Retinal fundus photograph
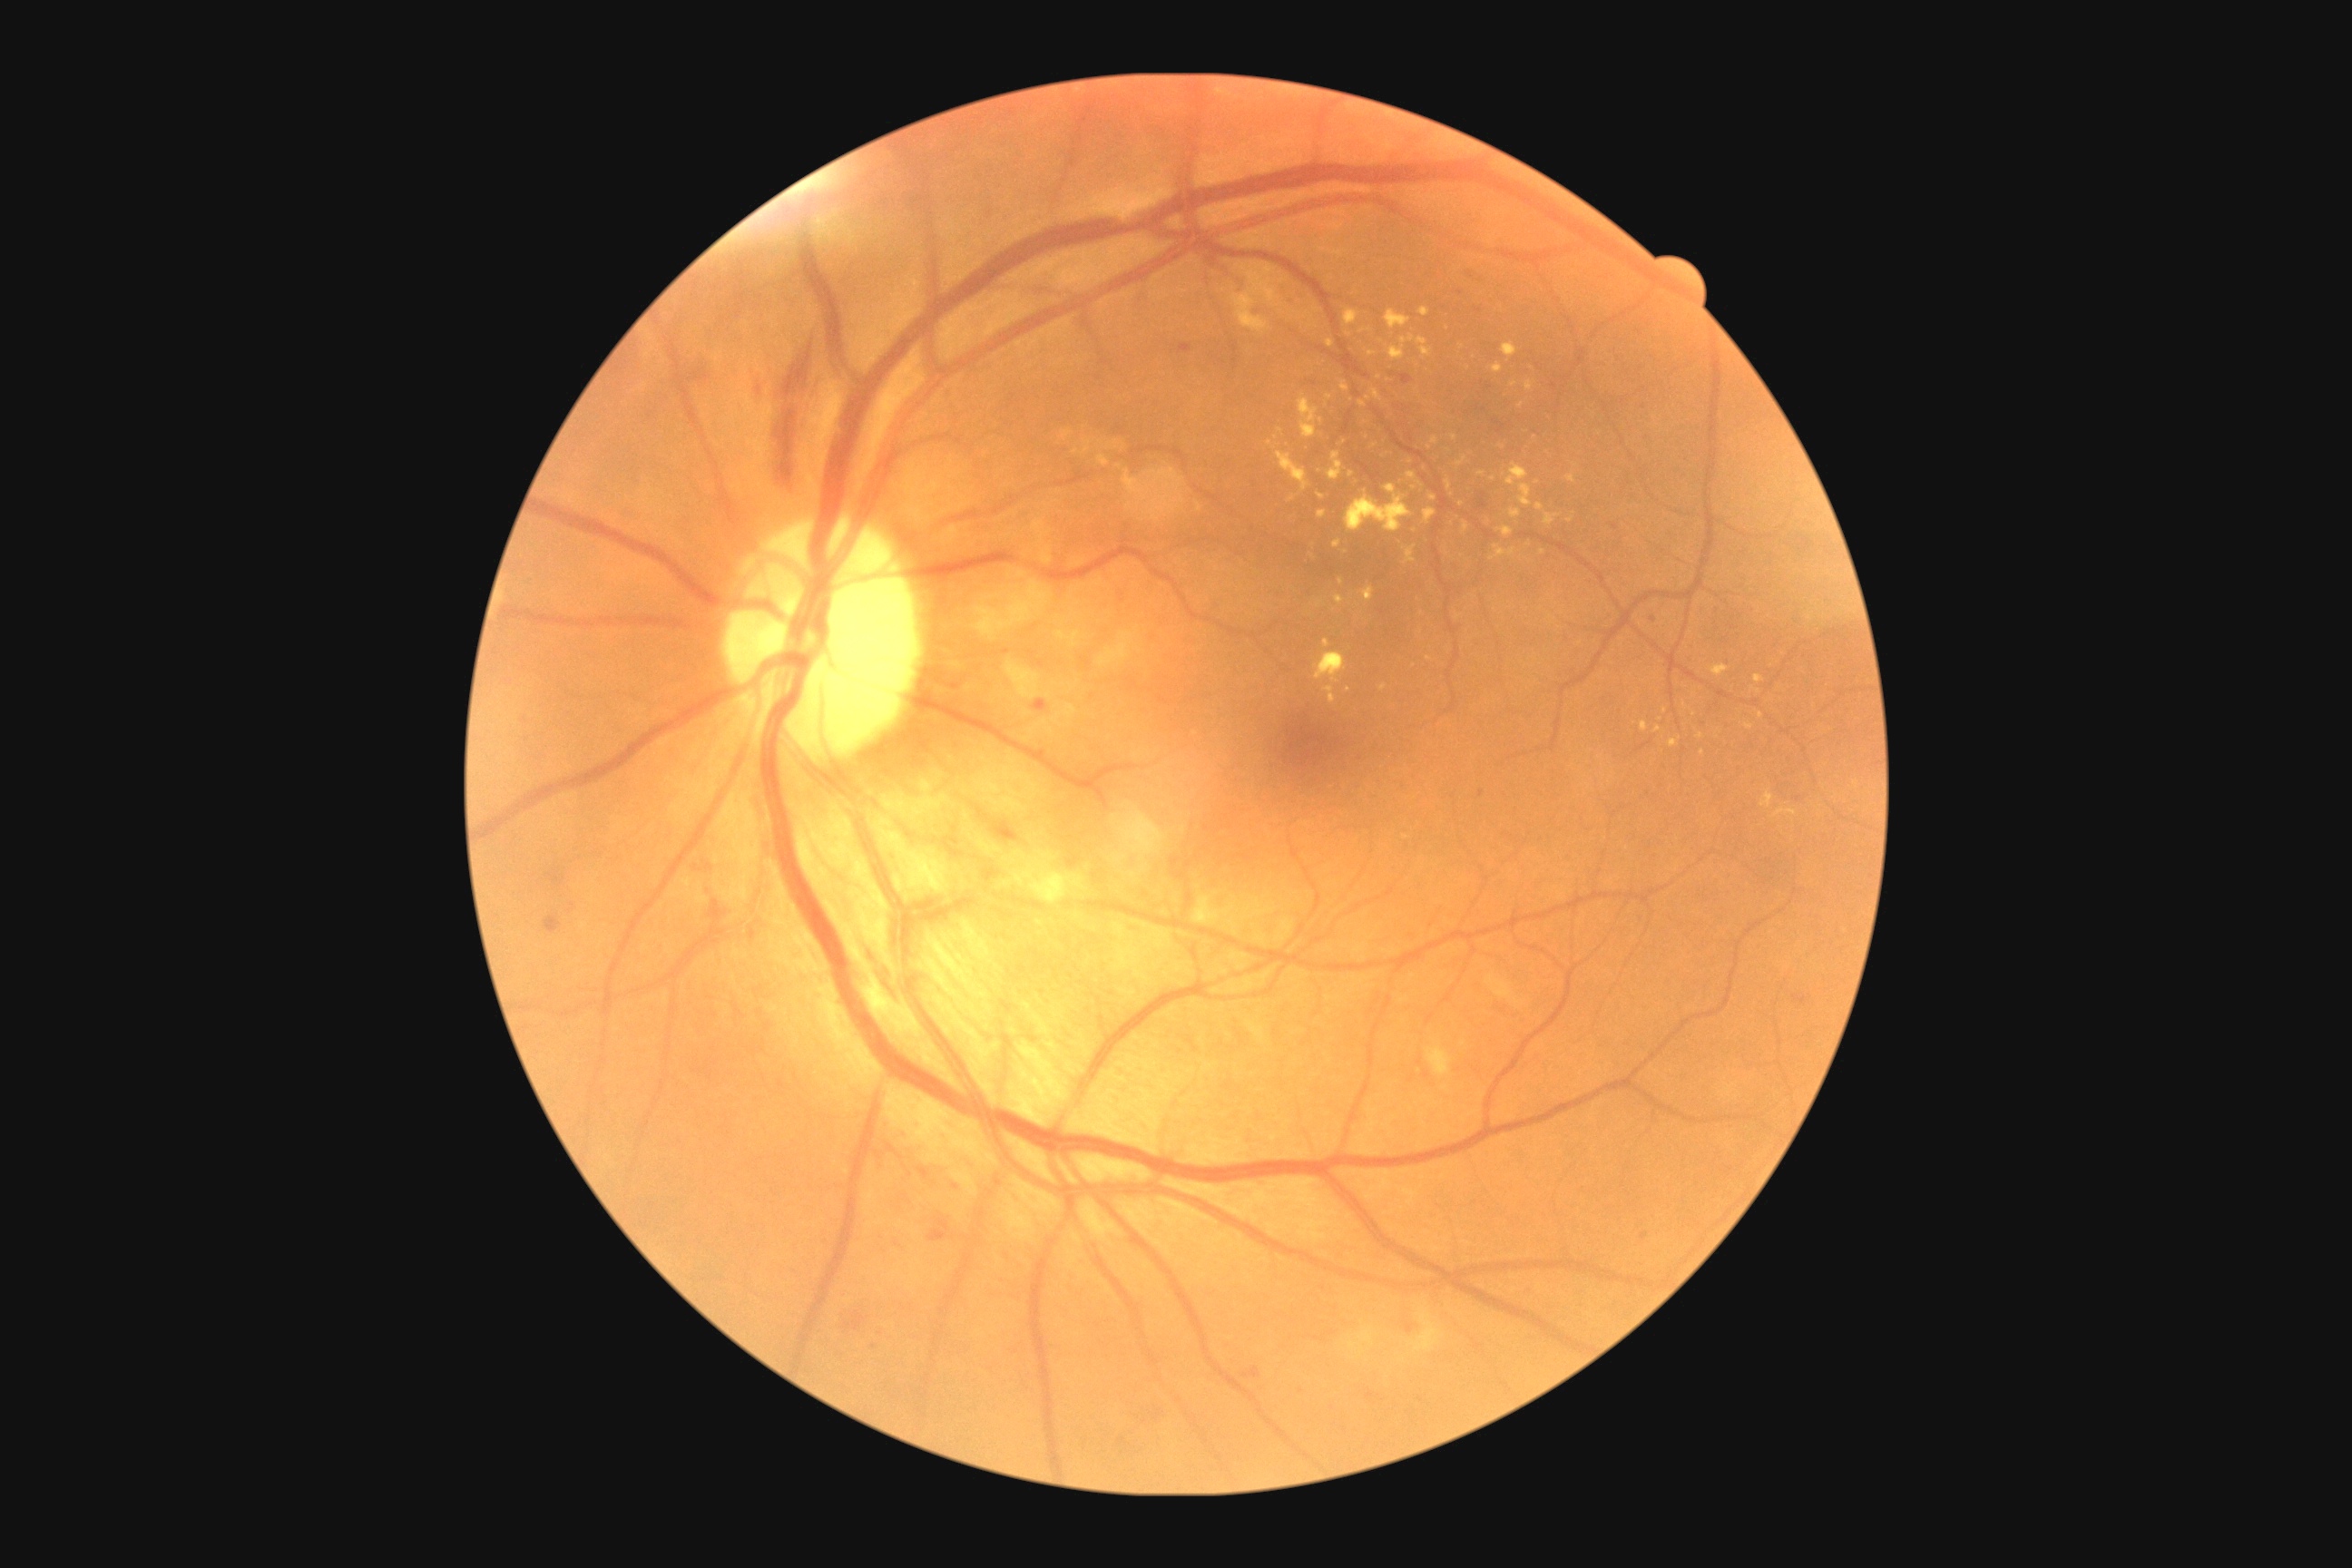

The retinopathy is classified as non-proliferative diabetic retinopathy. DR: 2/4.